2352 x 1568 pixels: 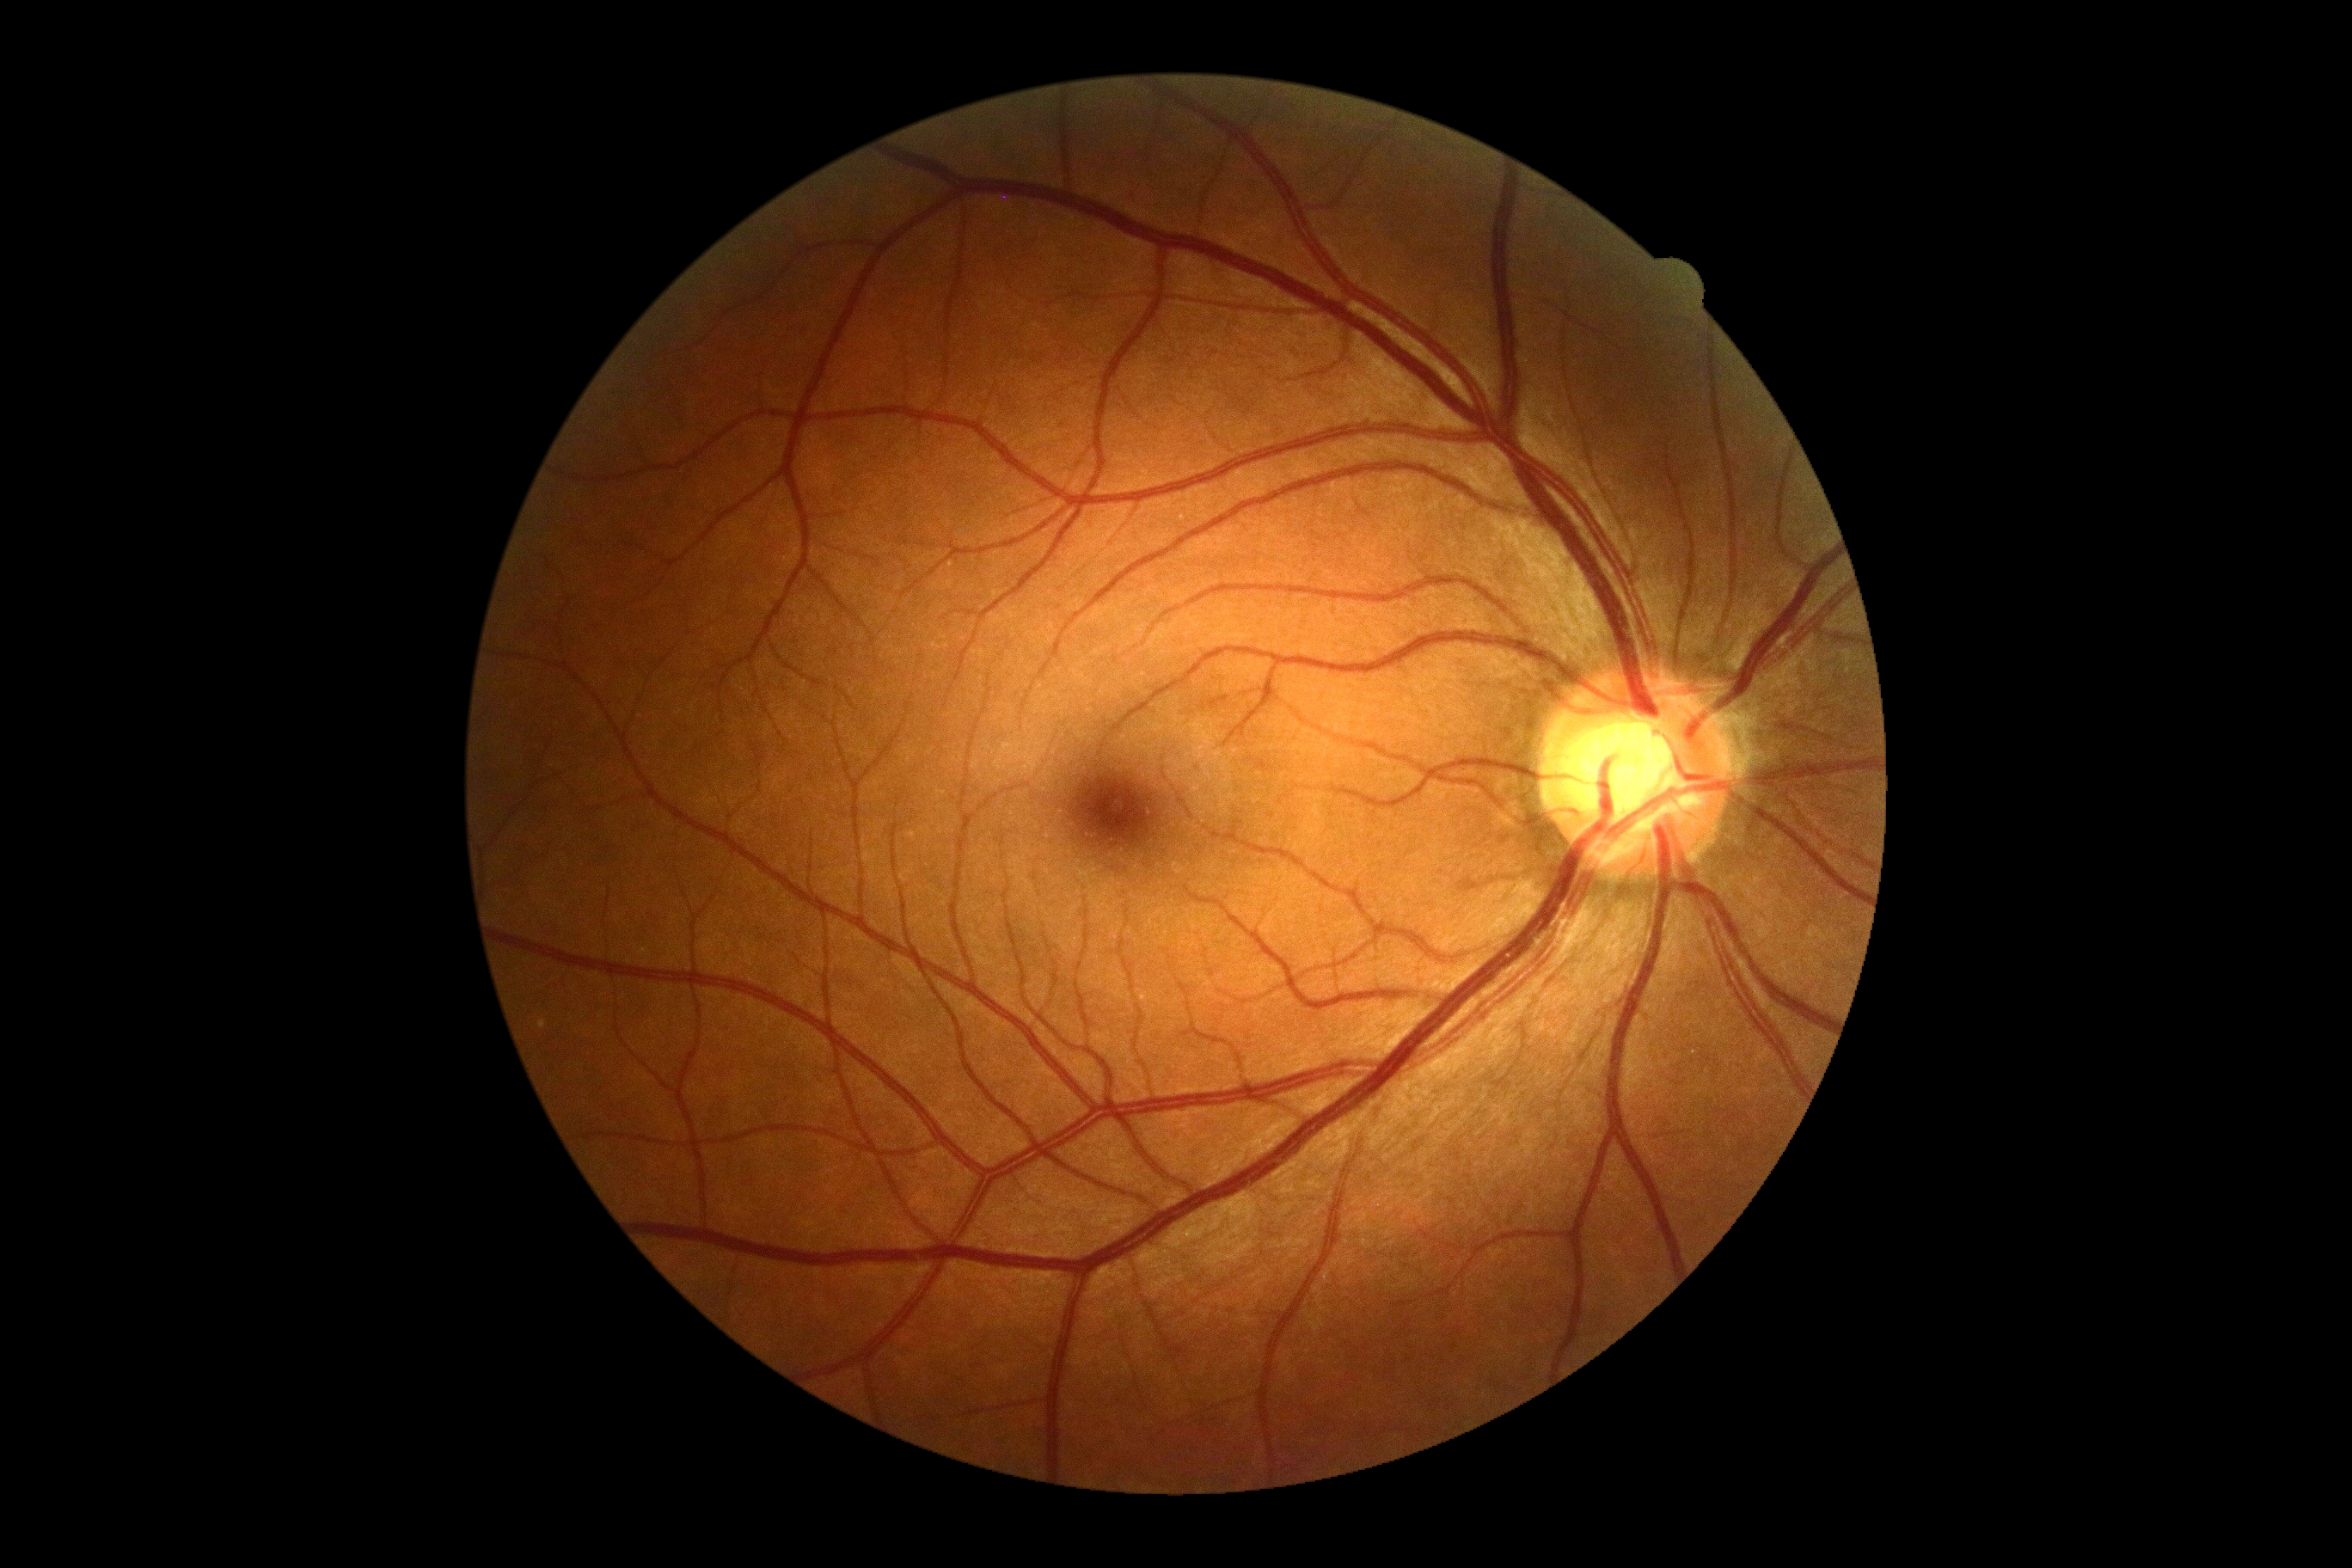
Diabetic retinopathy (DR) is 0.